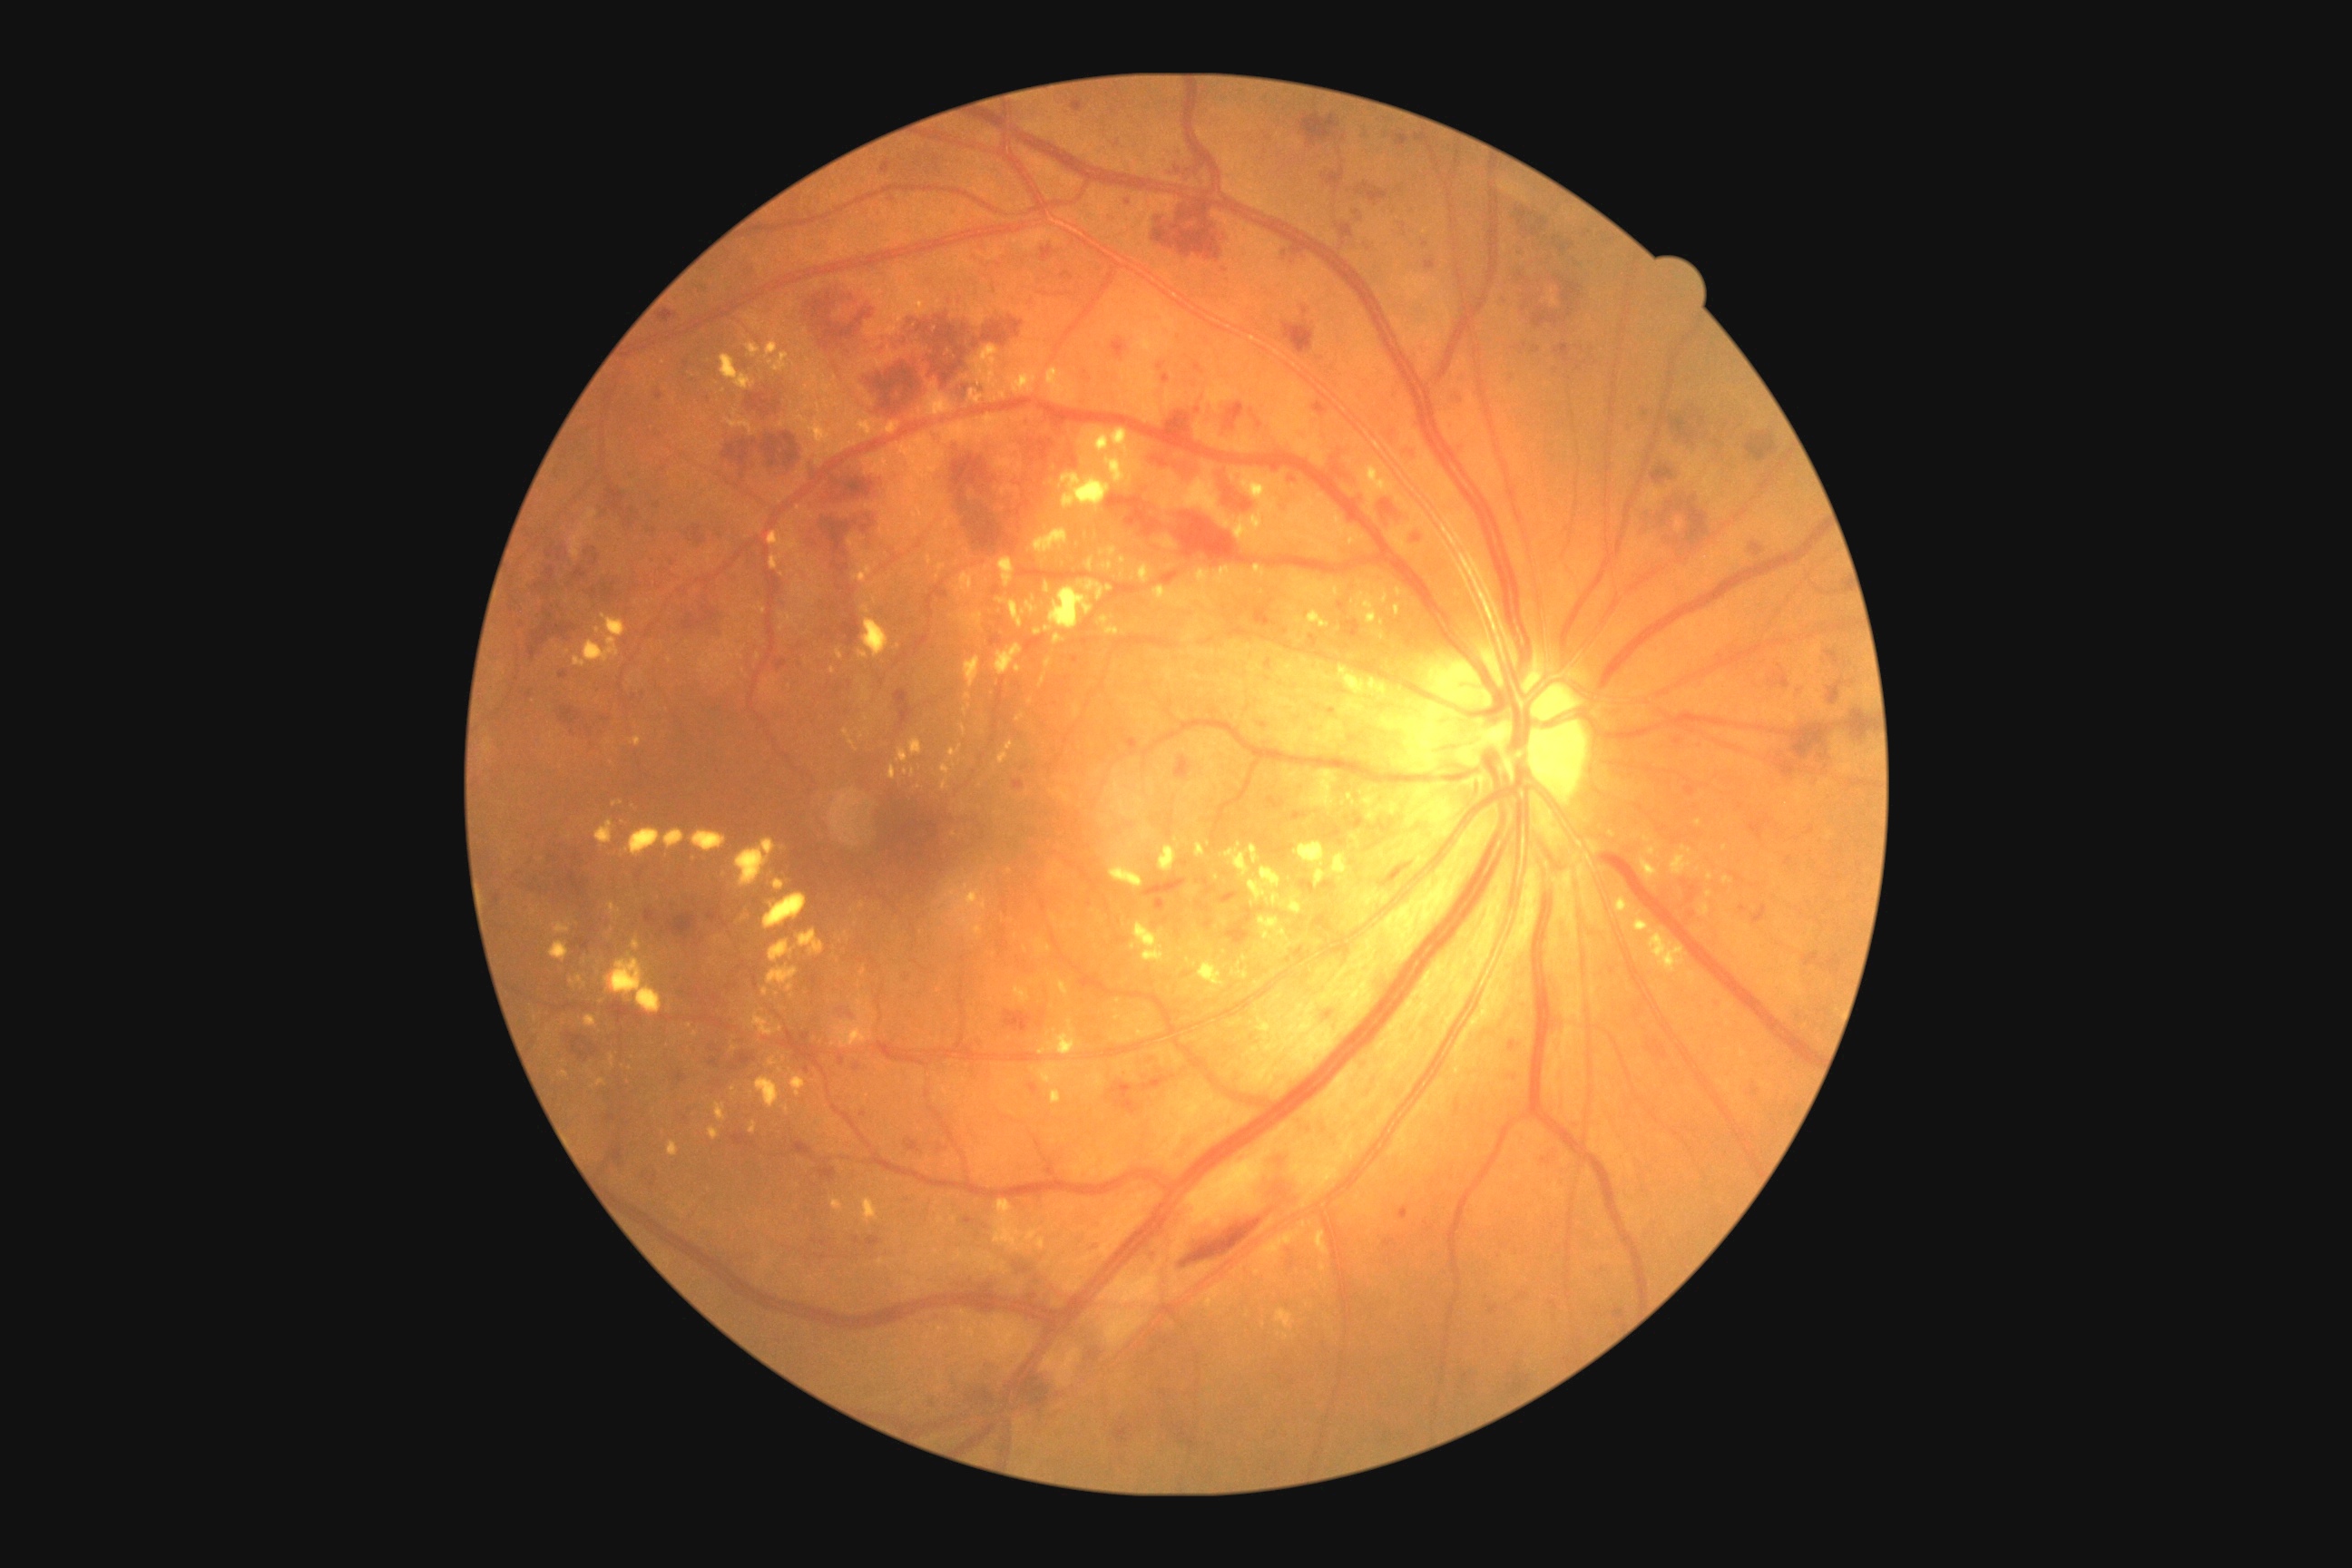

{"partial":true,"dr_grade":3,"dr_grade_name":"severe NPDR","lesions":{"ex":[[956,573,977,594],[750,1014,783,1037],[1110,841,1144,890],[714,936,721,945],[667,1142,678,1157],[1186,957,1199,968],[854,565,872,585],[858,651,868,660],[937,564,945,571],[583,1015,598,1028],[941,881,986,936],[836,1021,872,1048],[1257,1021,1271,1041],[769,1057,778,1066]],"ex_small_approx":[[968,697],[870,587],[862,737],[536,1020],[734,1090]]}}